FOV: 45 degrees · 848x848 · diabetic retinopathy graded by the modified Davis classification: 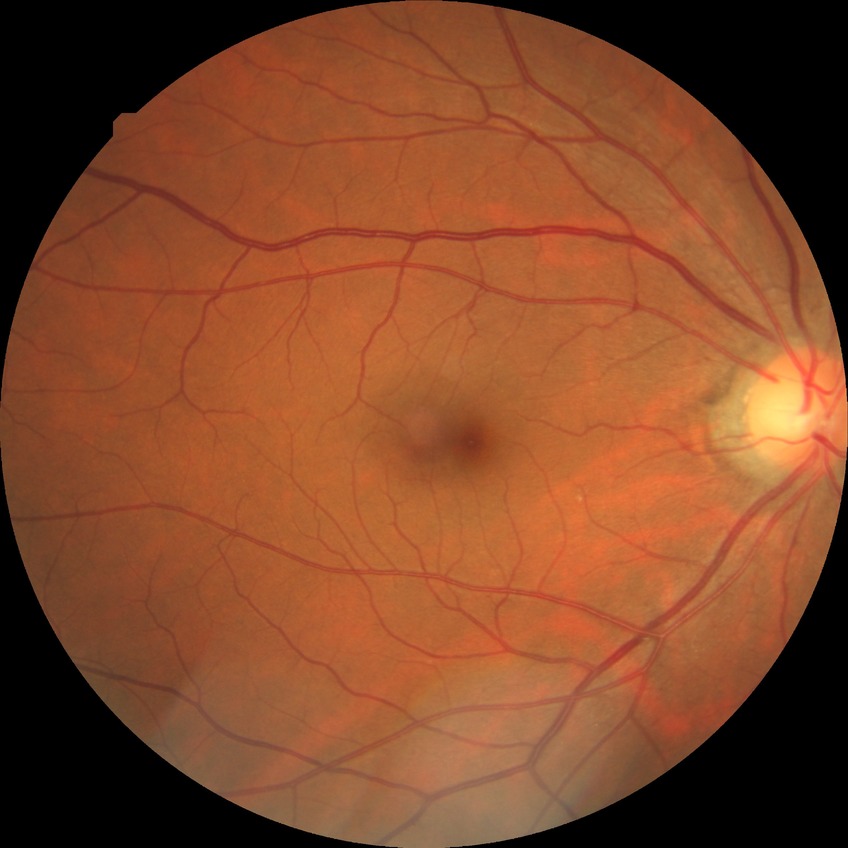

davis_grade: no diabetic retinopathy